Fundus photo
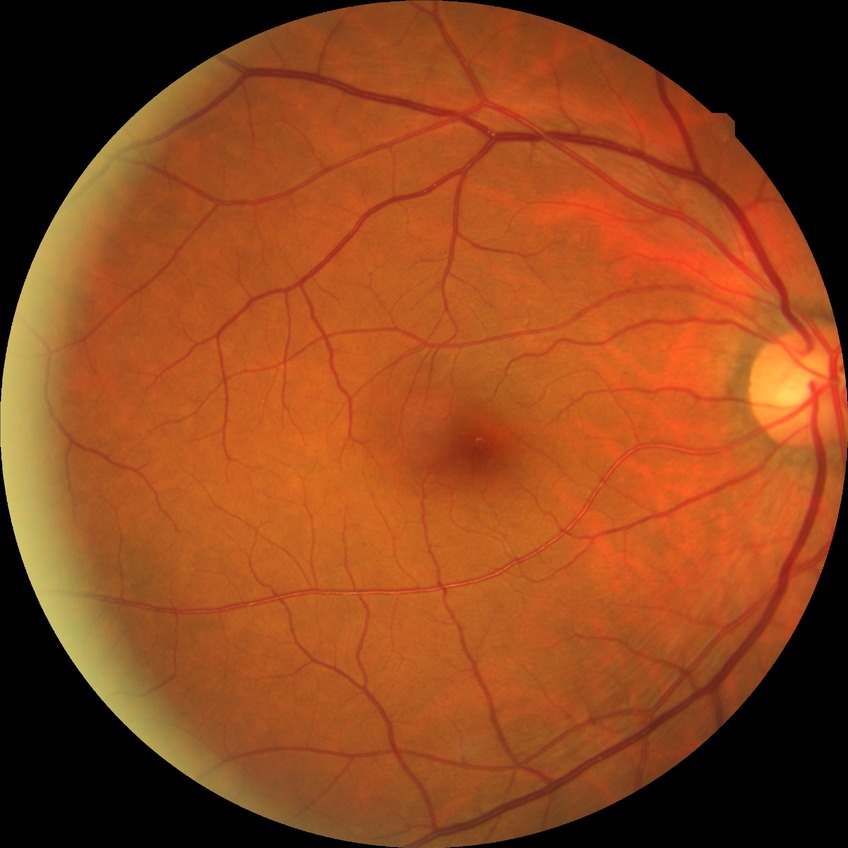
diabetic retinopathy (DR) = NDR (no diabetic retinopathy).